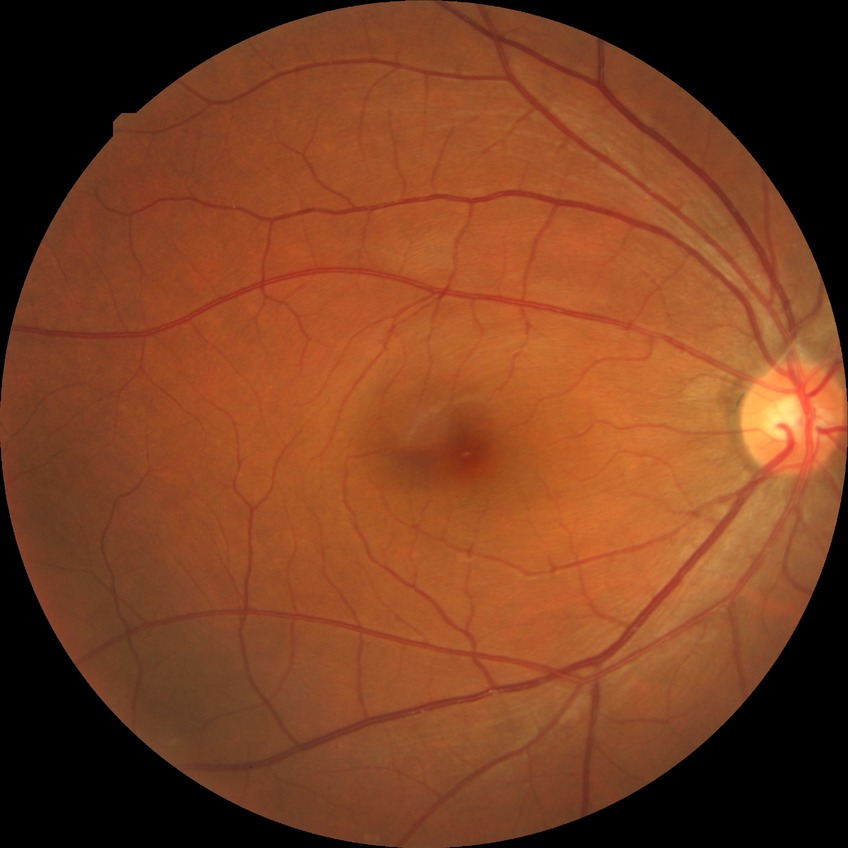

retinopathy grade@no diabetic retinopathy.